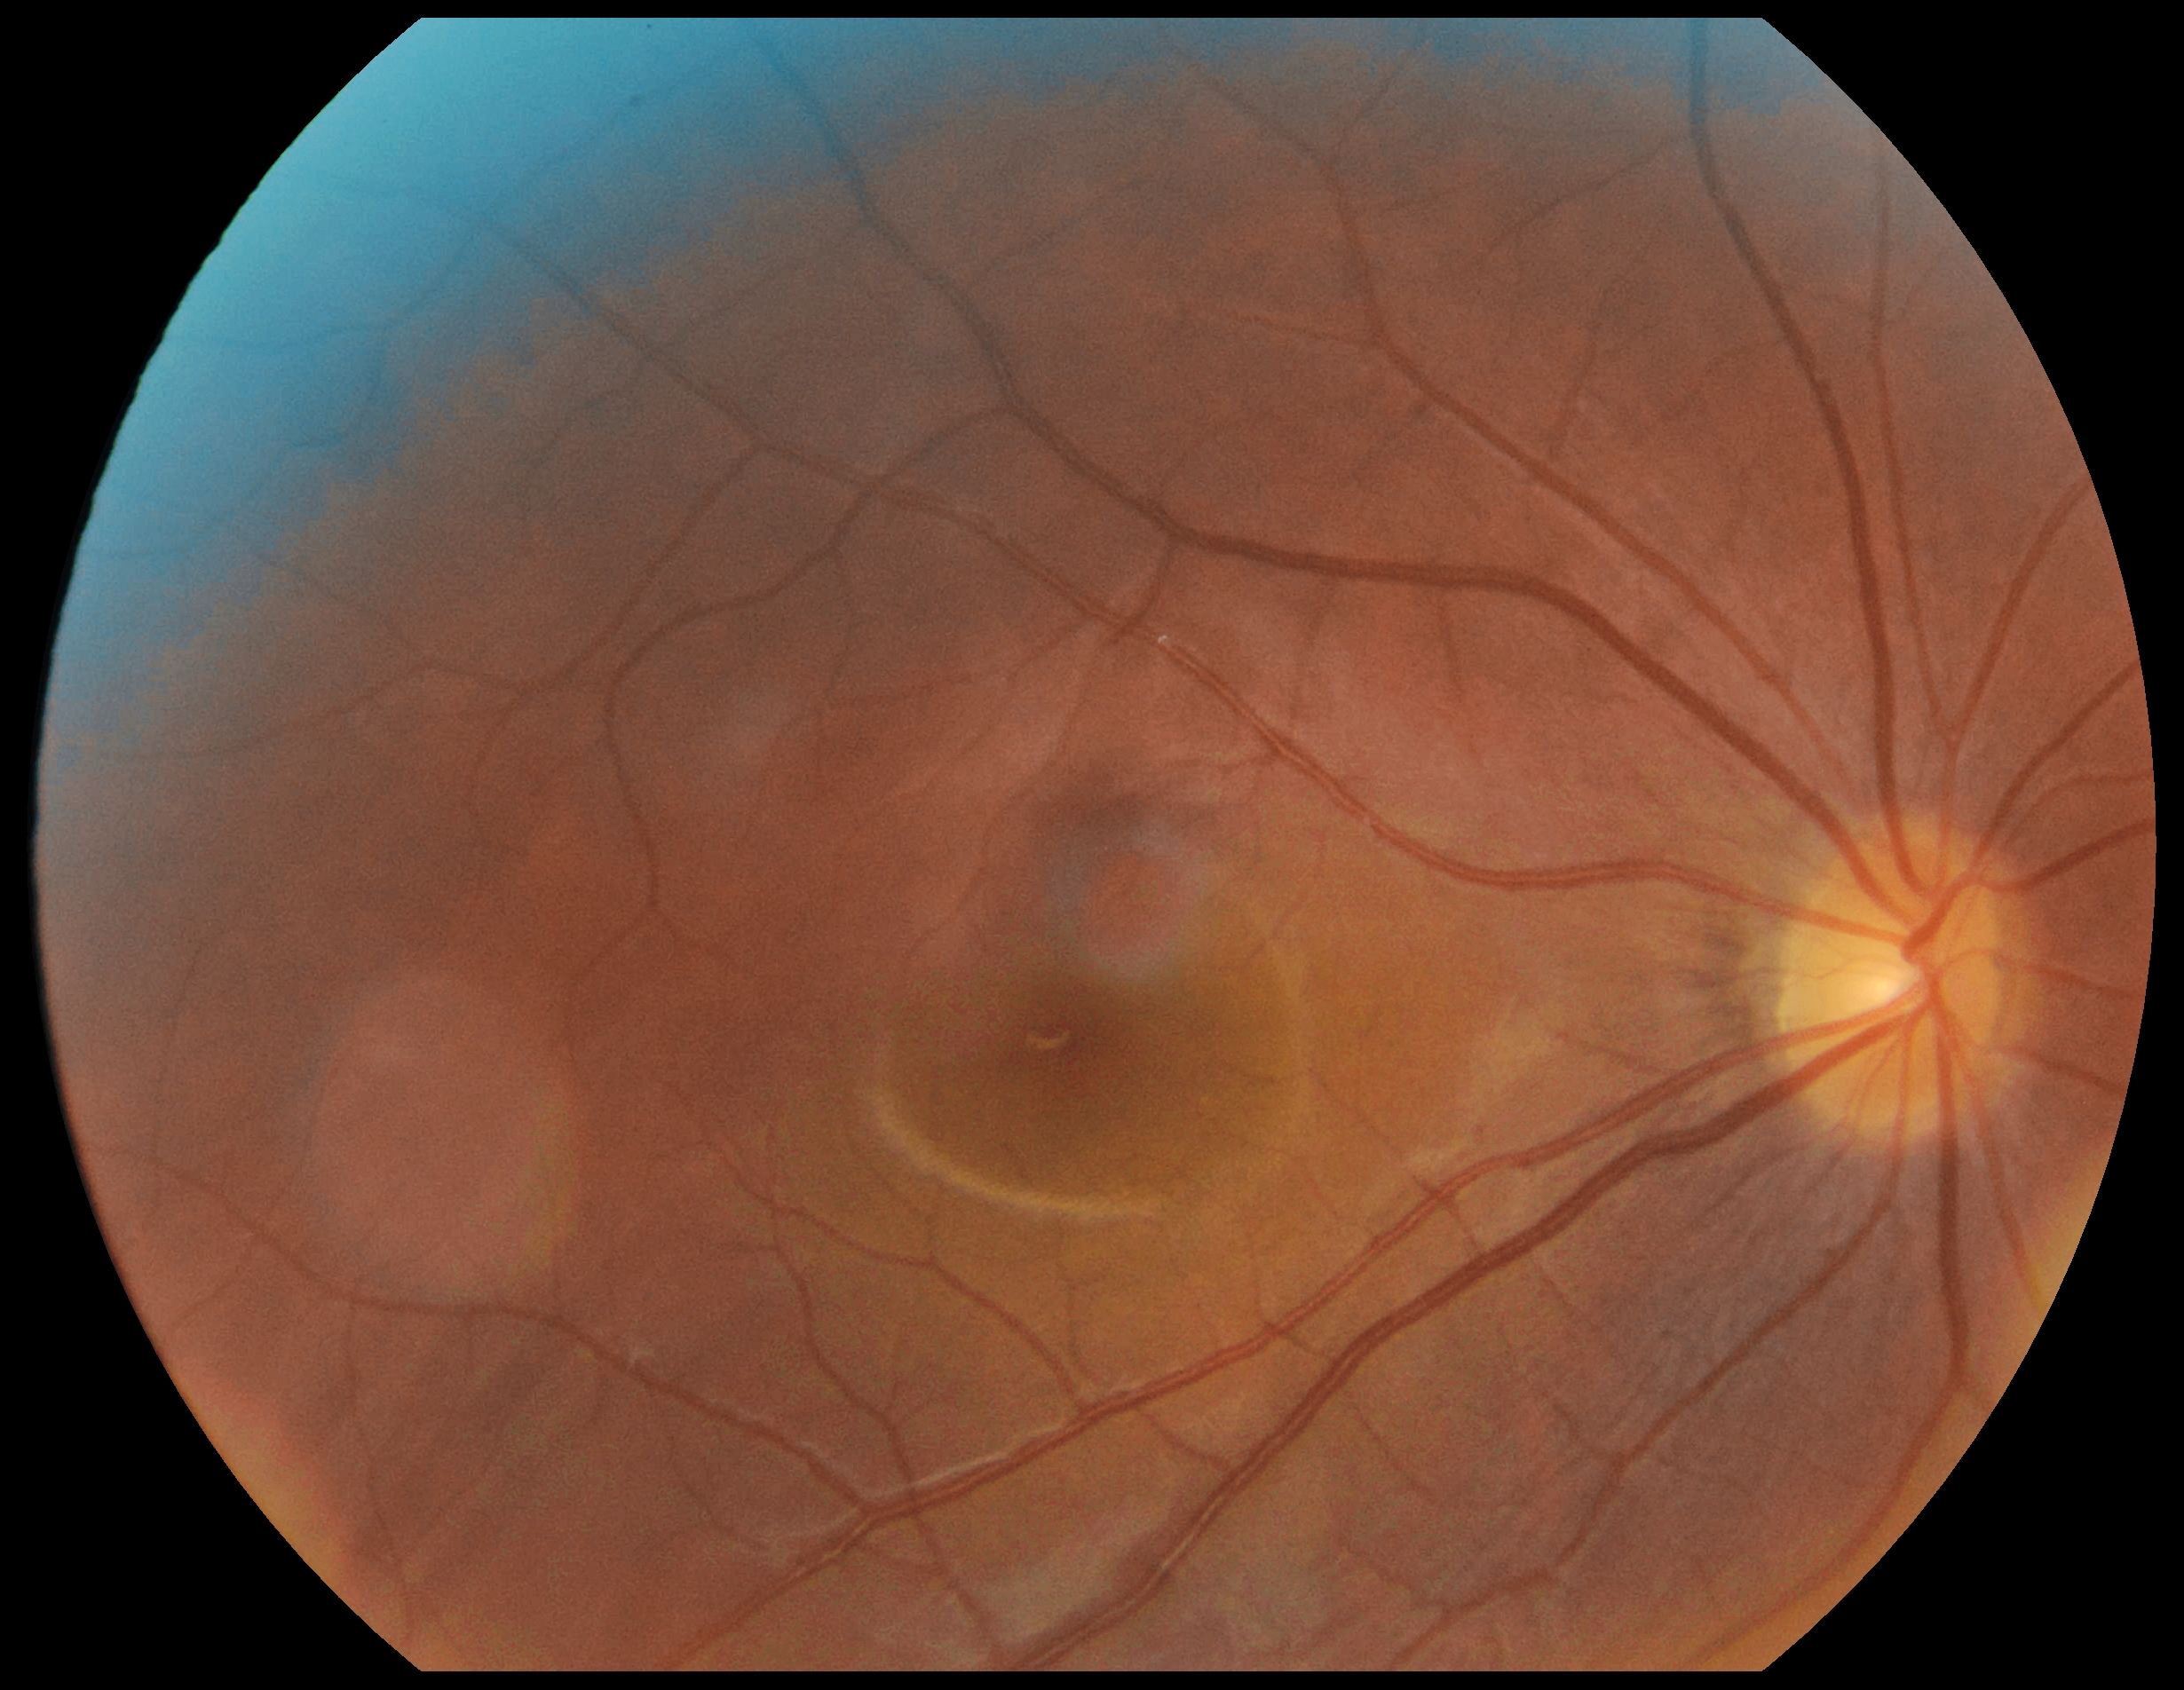 Diabetic retinopathy (DR) is 0/4.